45-degree field of view, image size 1960x1897, retinal fundus photograph — 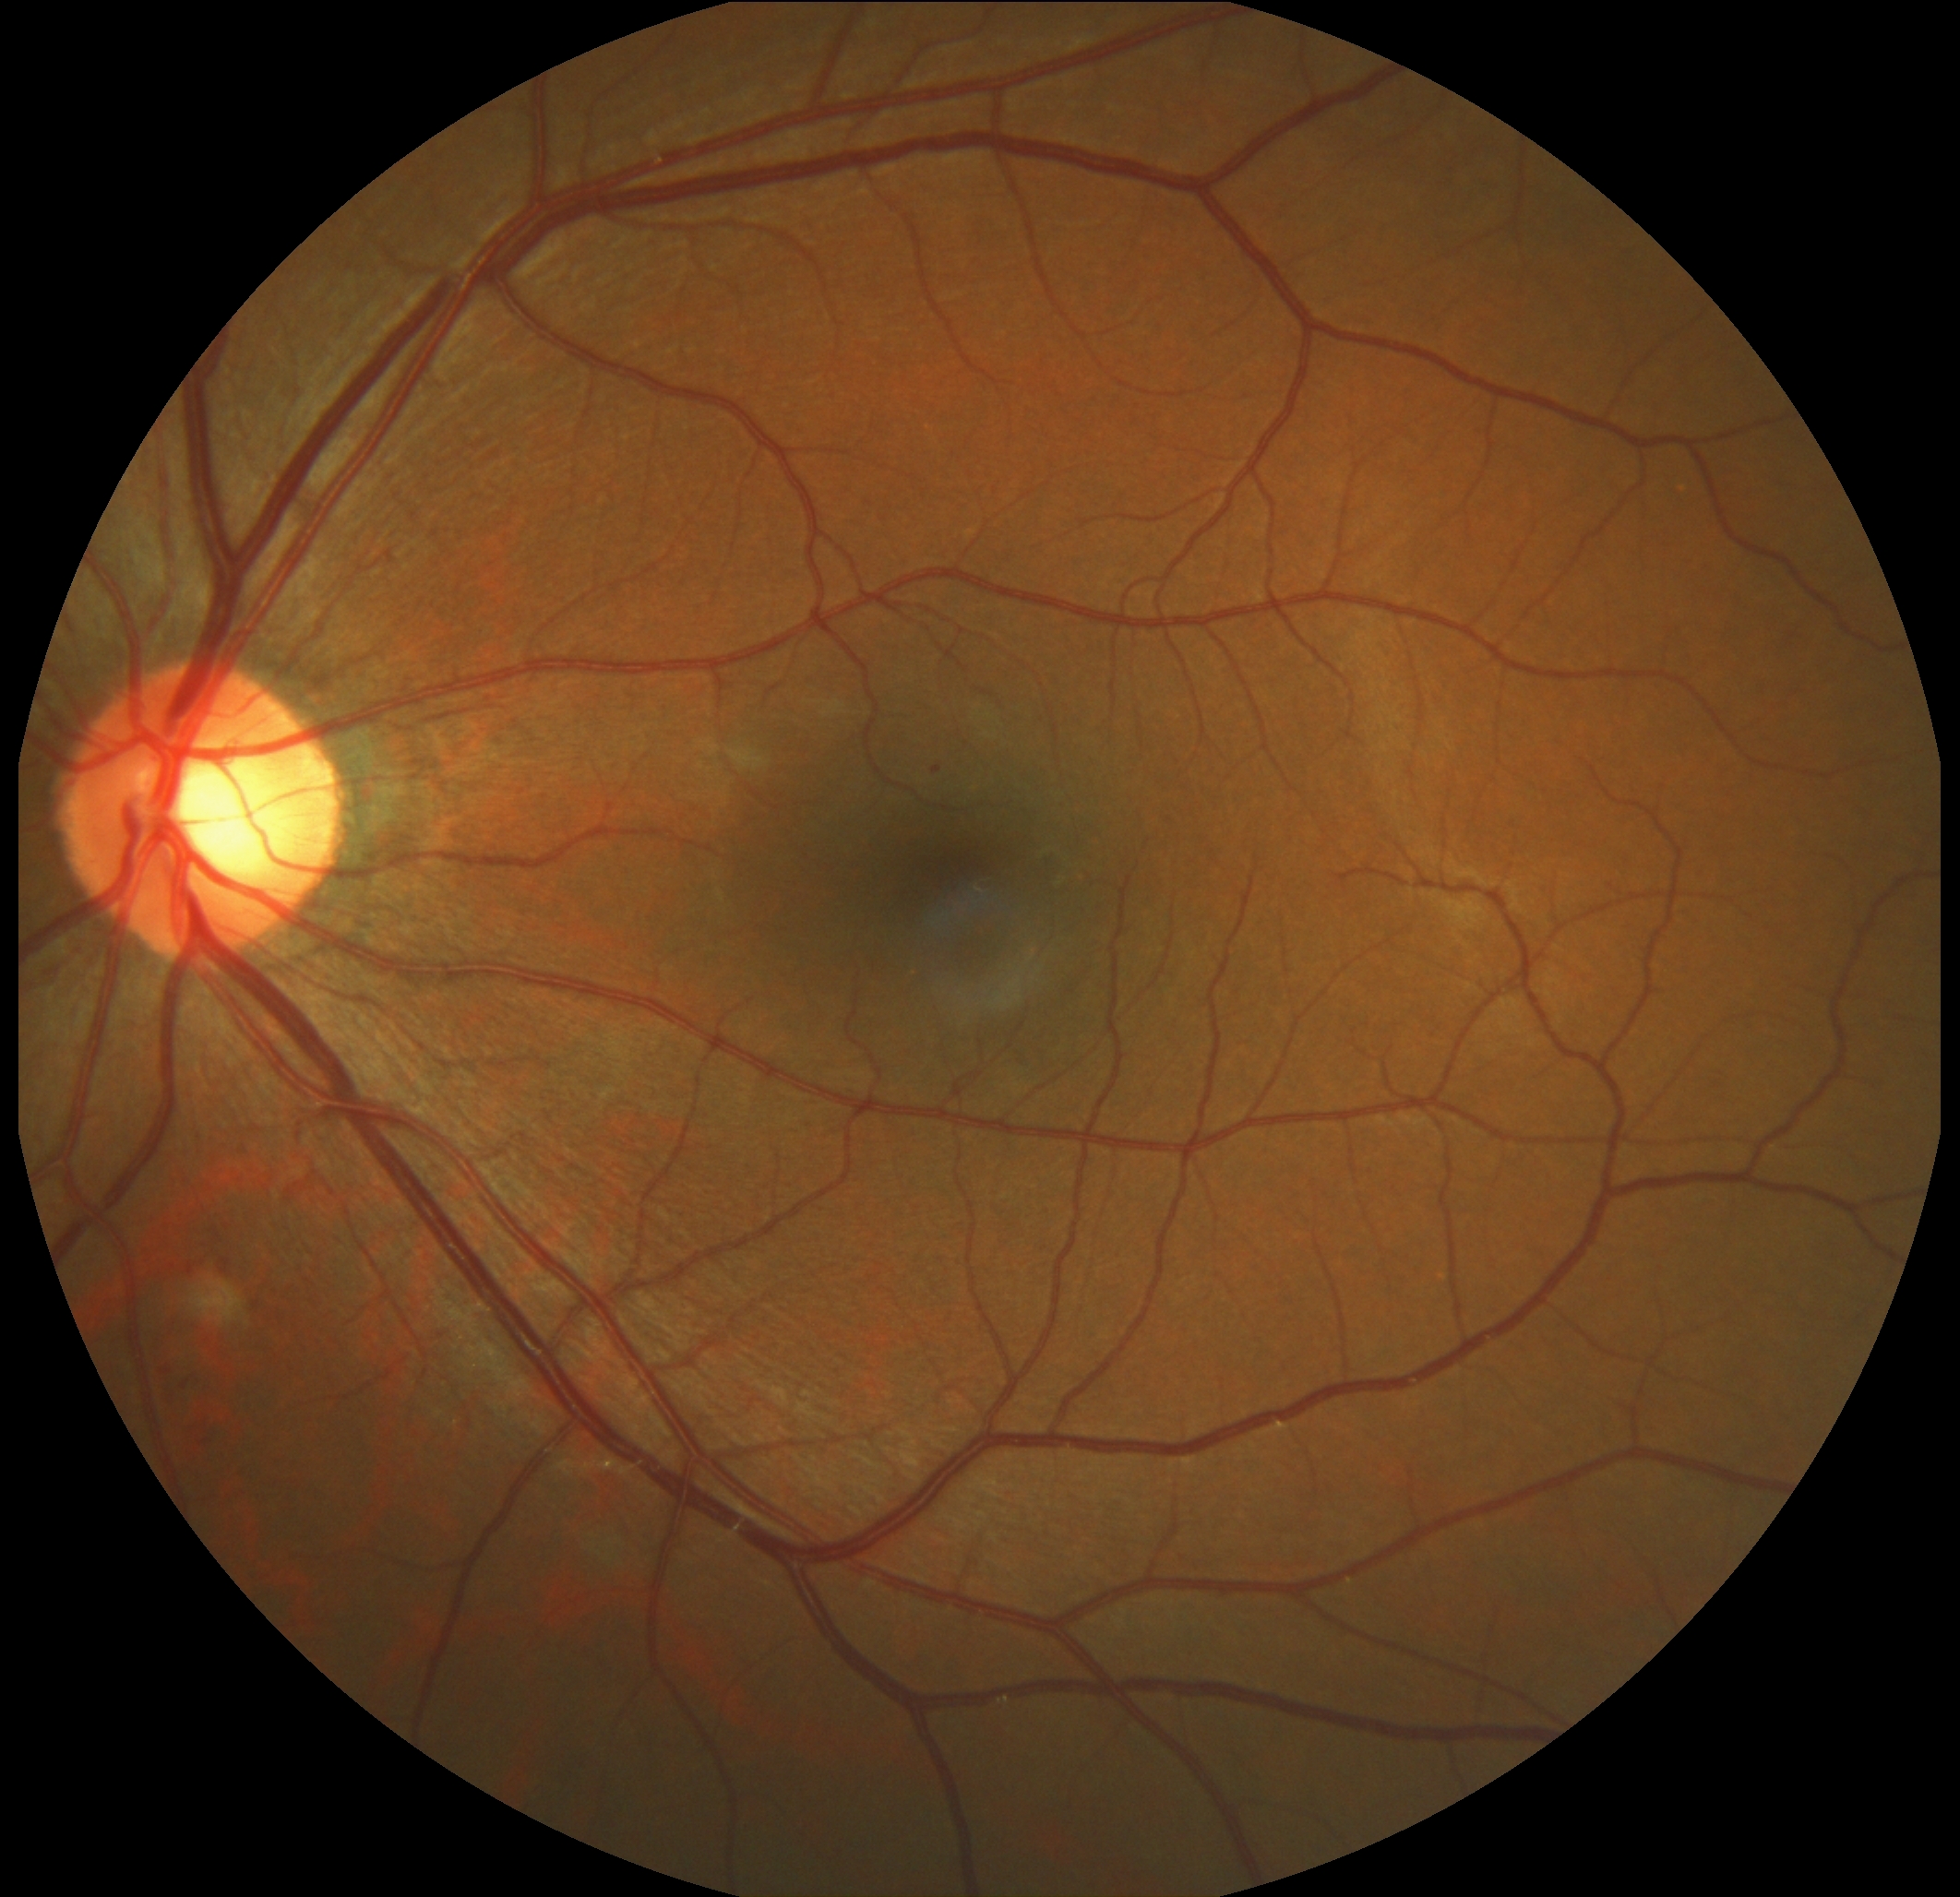
Findings:
- DR stage: moderate non-proliferative diabetic retinopathy (grade 2) — more than just microaneurysms but less than severe NPDR